45° FOV · 2212x1672px
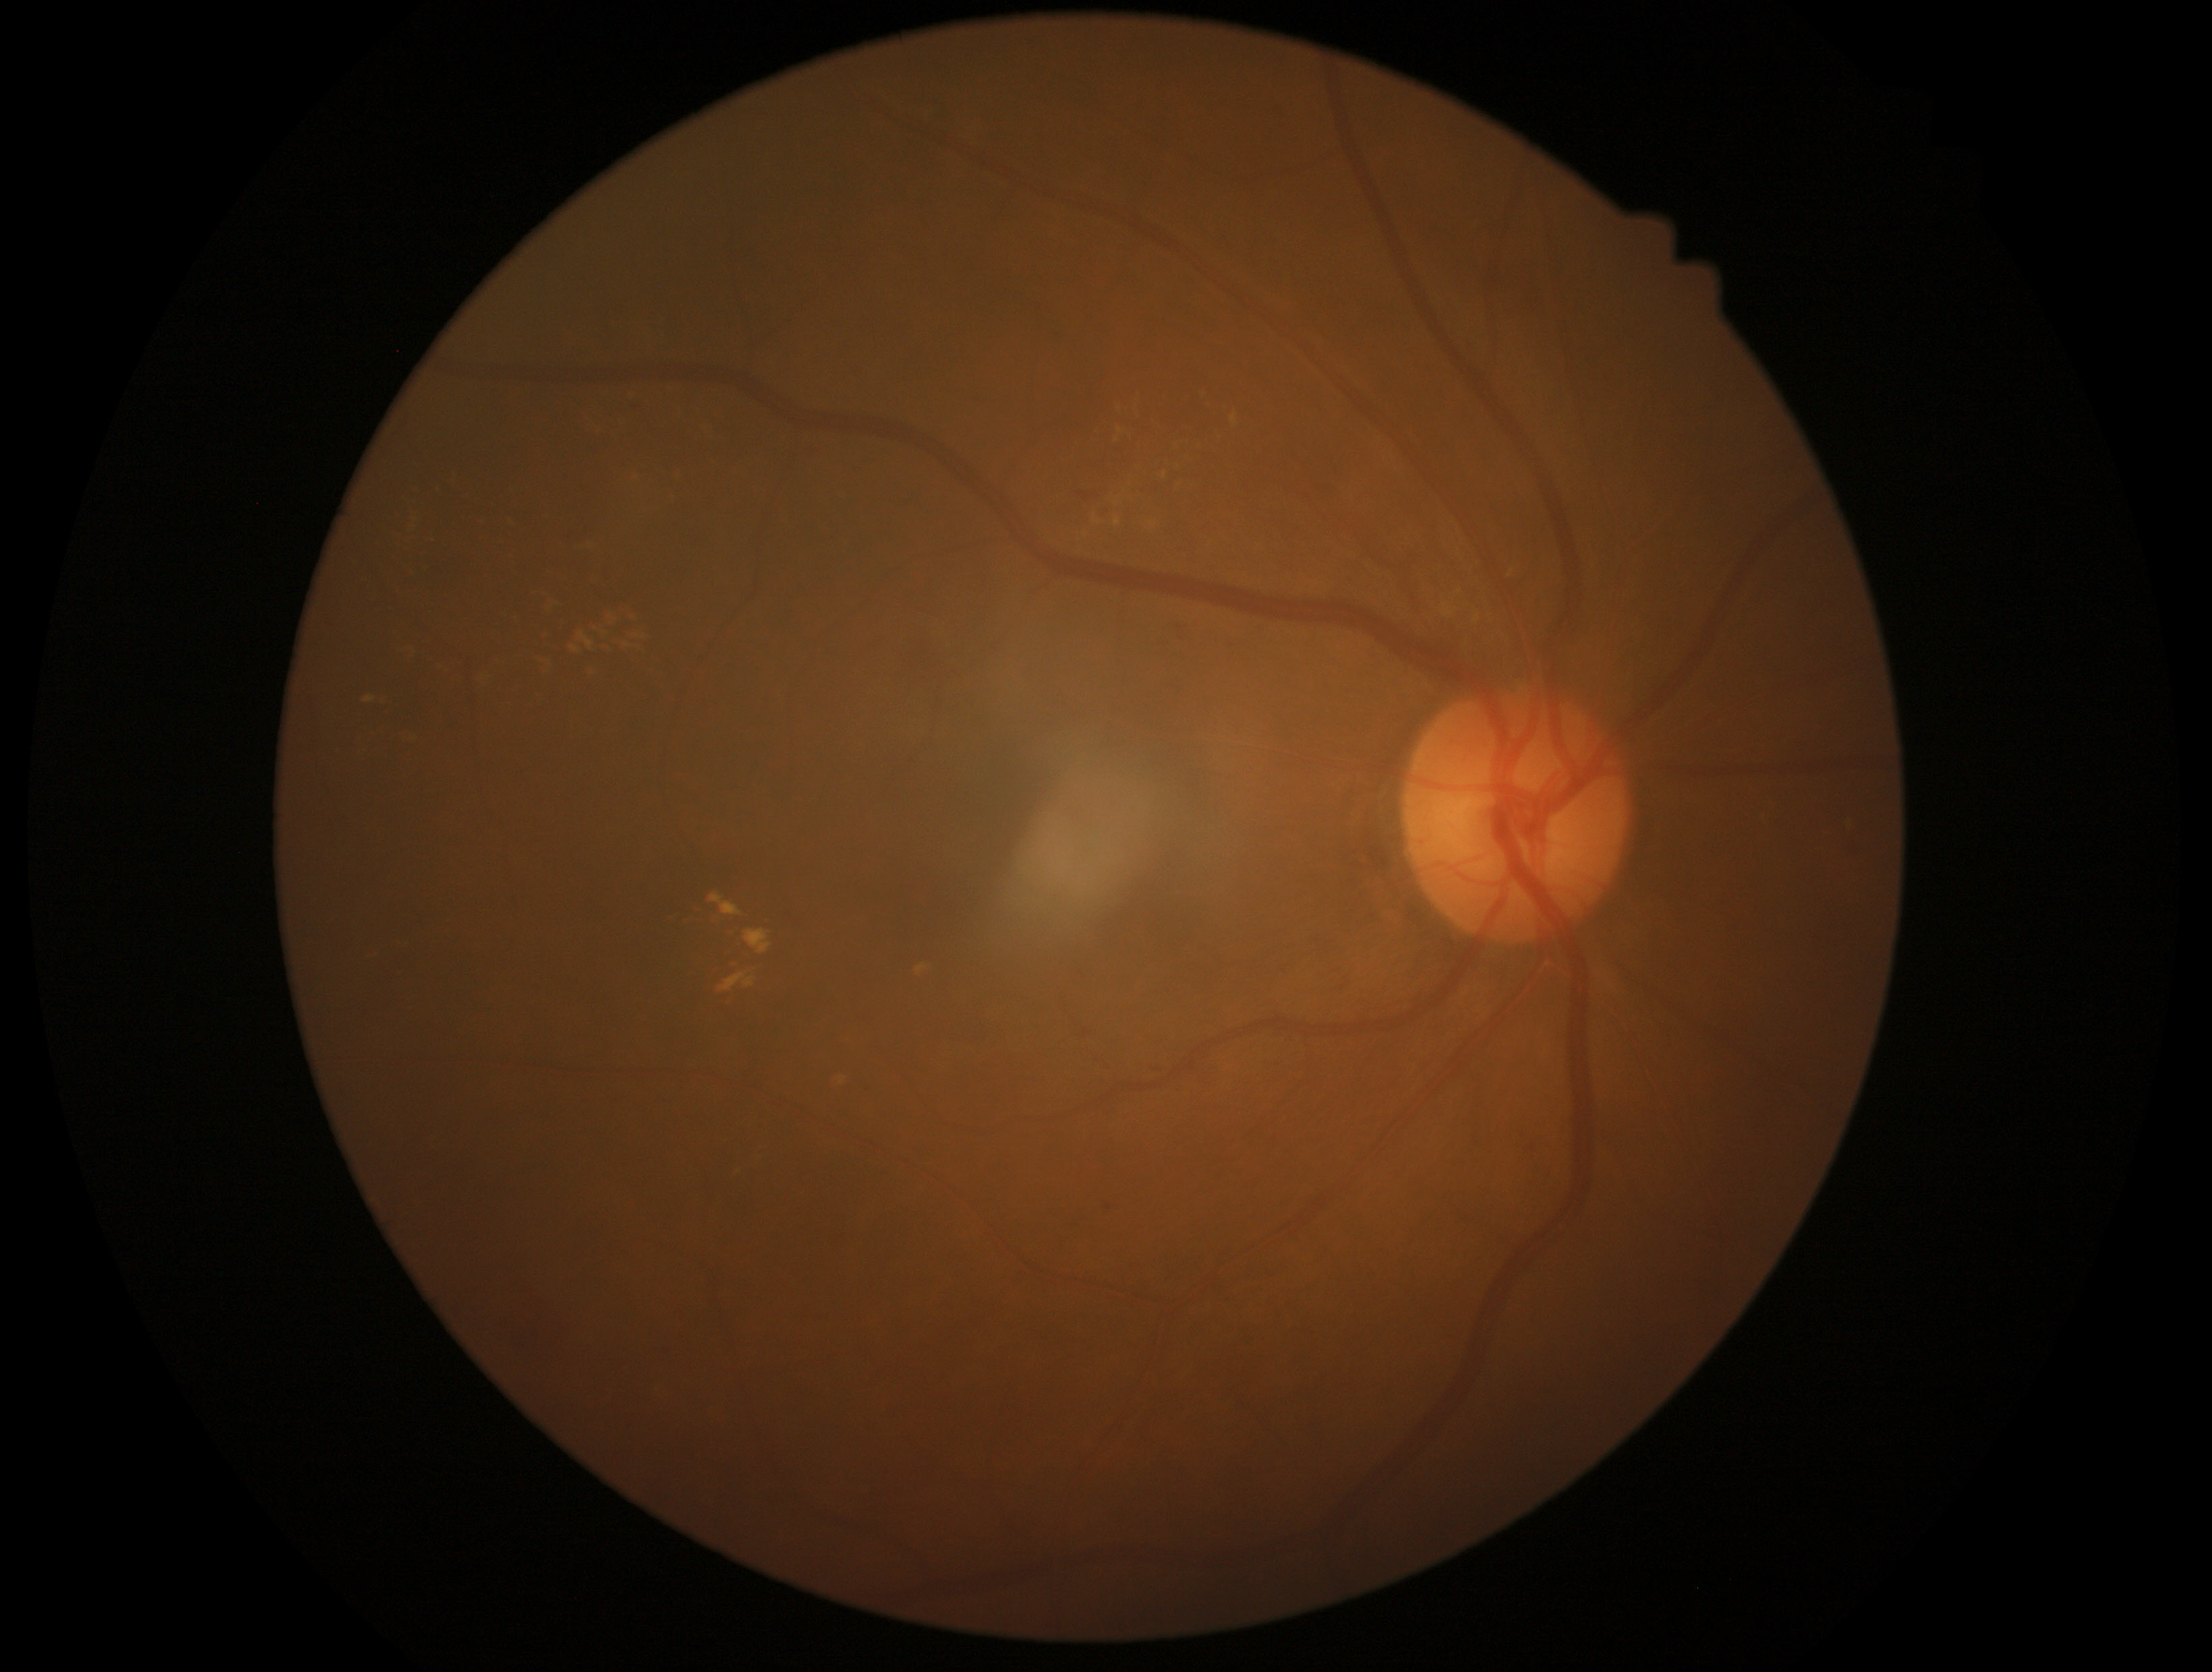

Diabetic retinopathy severity is moderate NPDR (grade 2).